45° FOV · retinal fundus photograph:
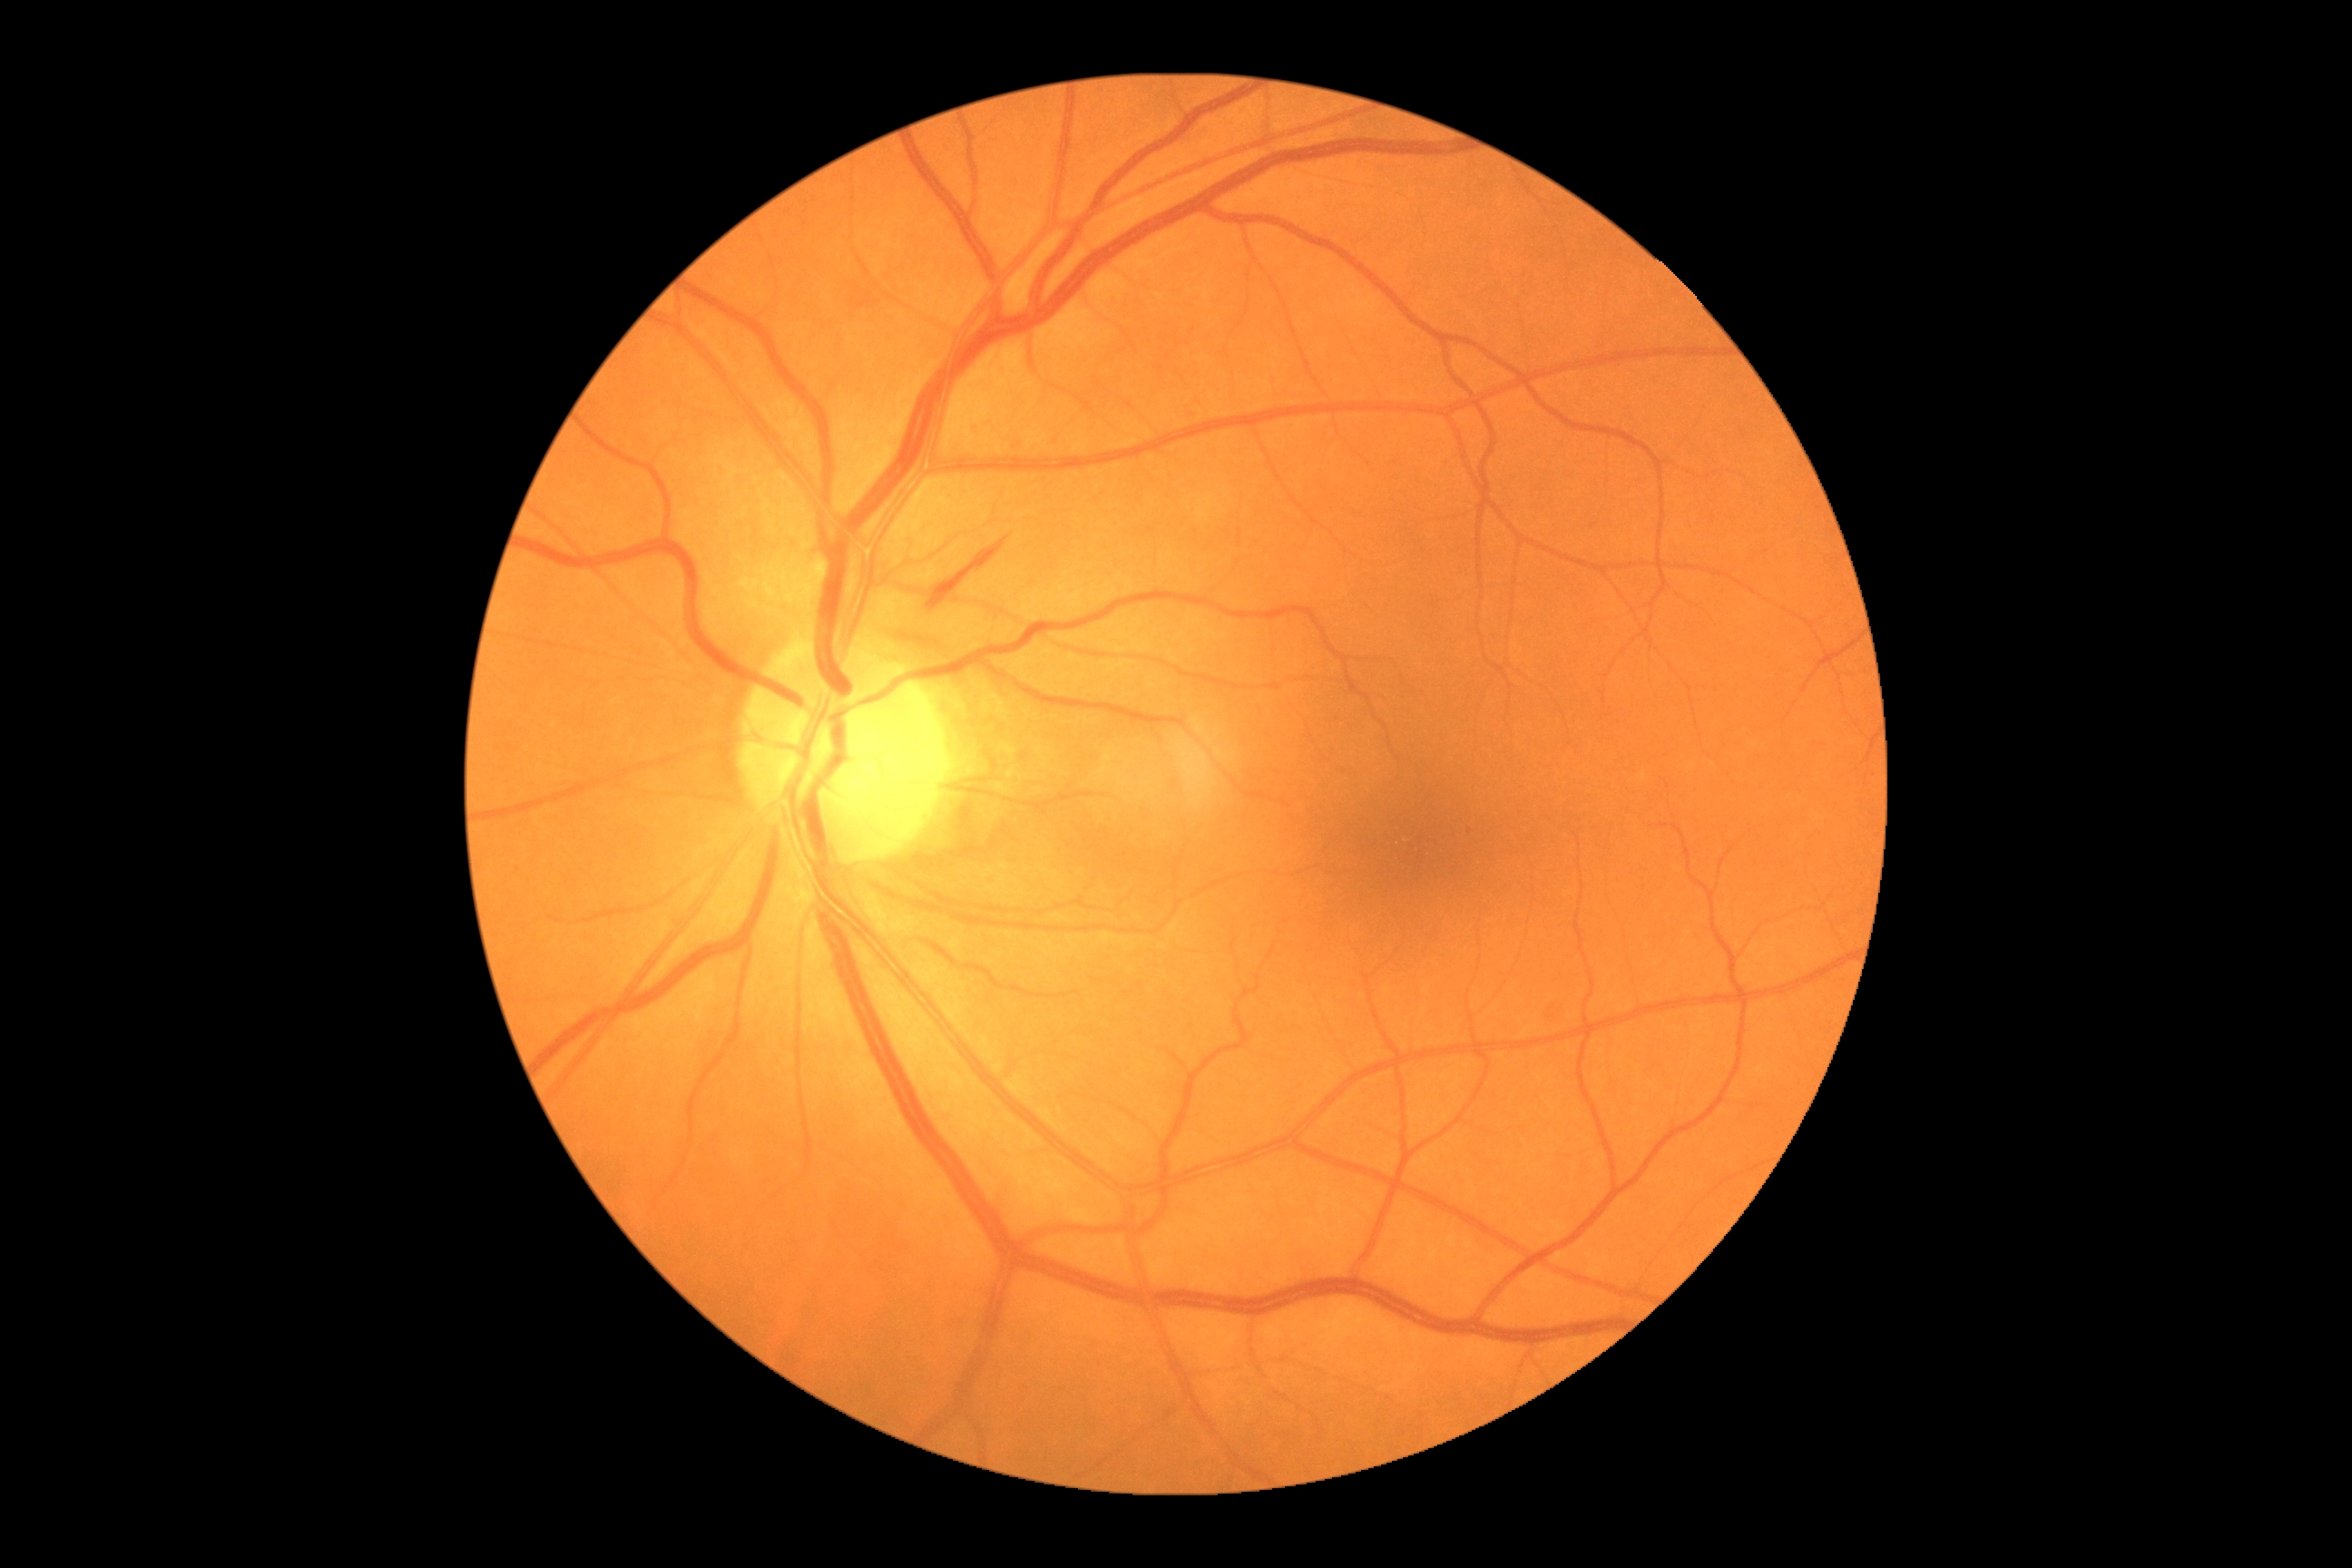
Diabetic retinopathy (DR): grade 2 (moderate NPDR).